130° field of view (Clarity RetCam 3); image size 640x480; infant wide-field retinal image: 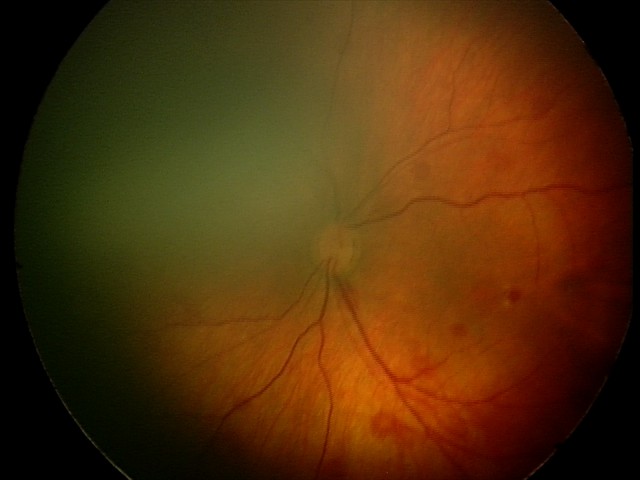

Examination diagnosed as retinal hemorrhages.